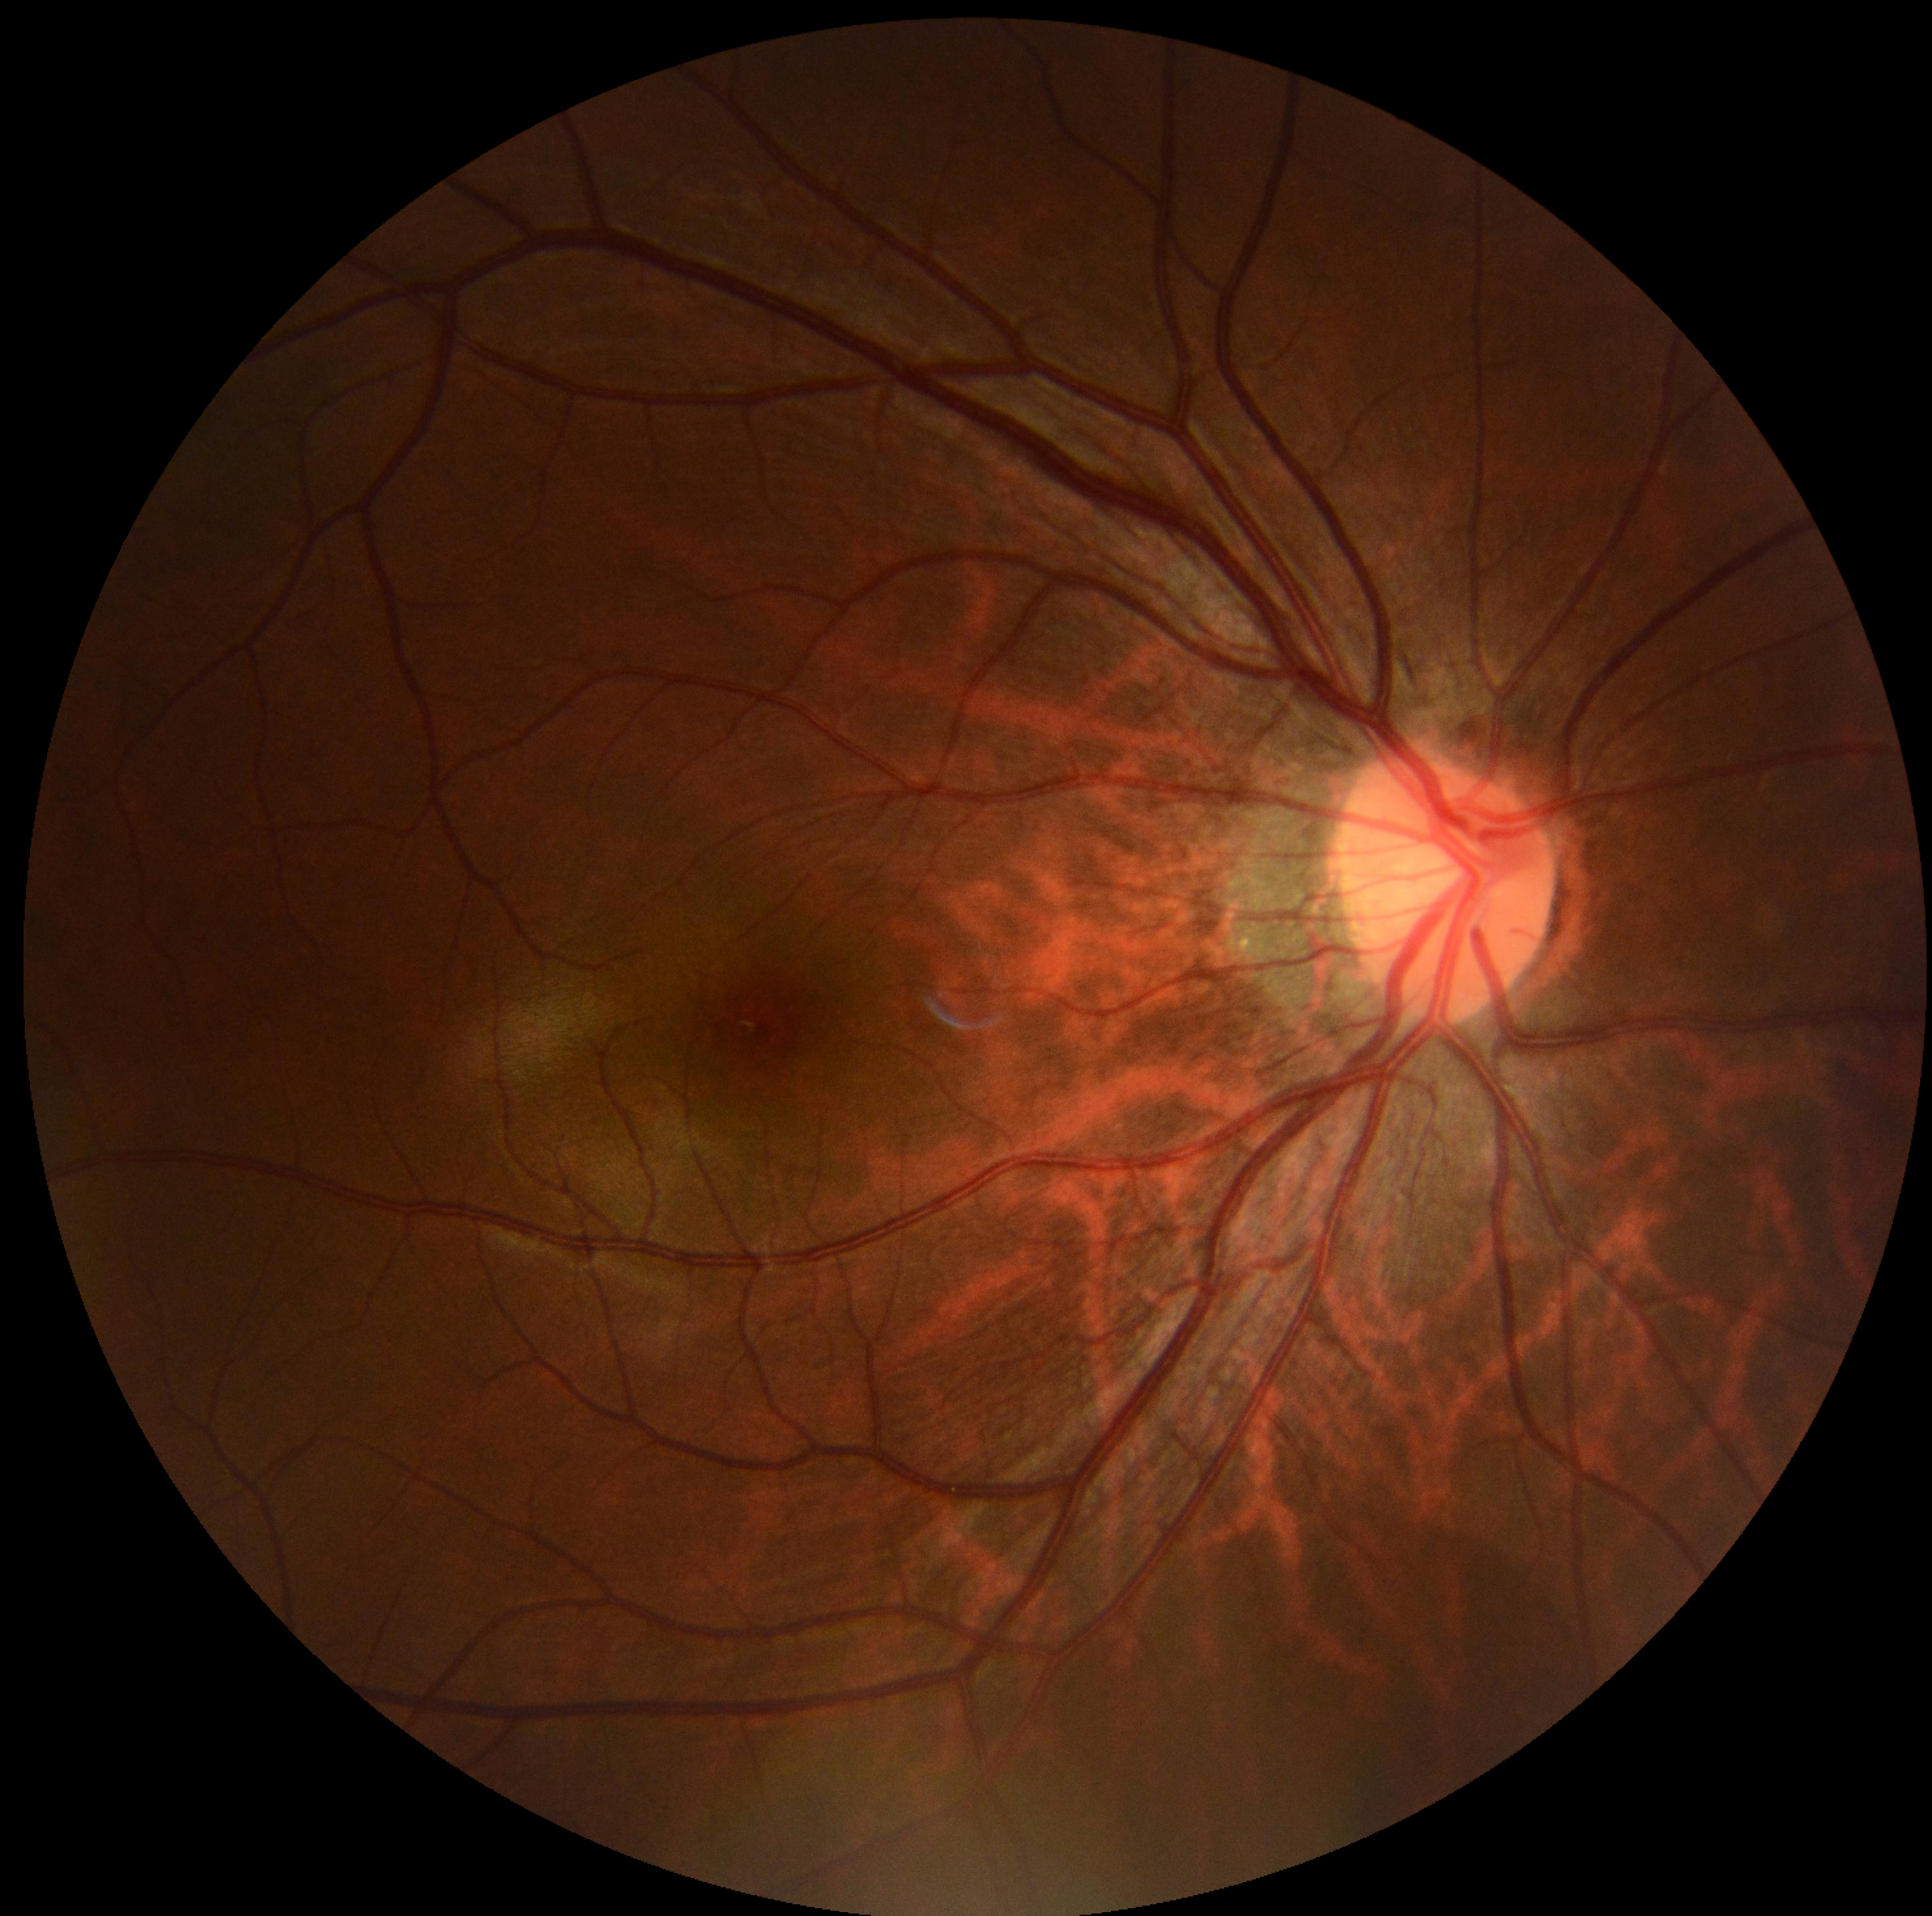
Diabetic retinopathy (DR) is 0/4 — no visible signs of diabetic retinopathy.